Color fundus photograph: 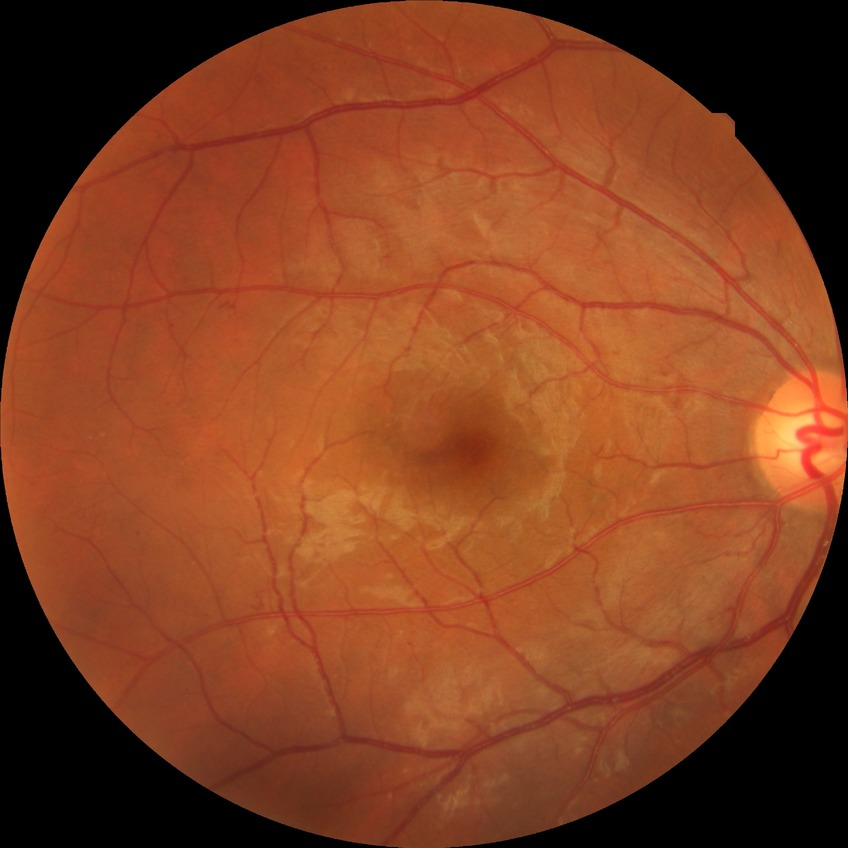 DR class: non-proliferative diabetic retinopathy, DR: SDR.